Retinal fundus photograph. 2048 x 1536 pixels. FOV: 45 degrees
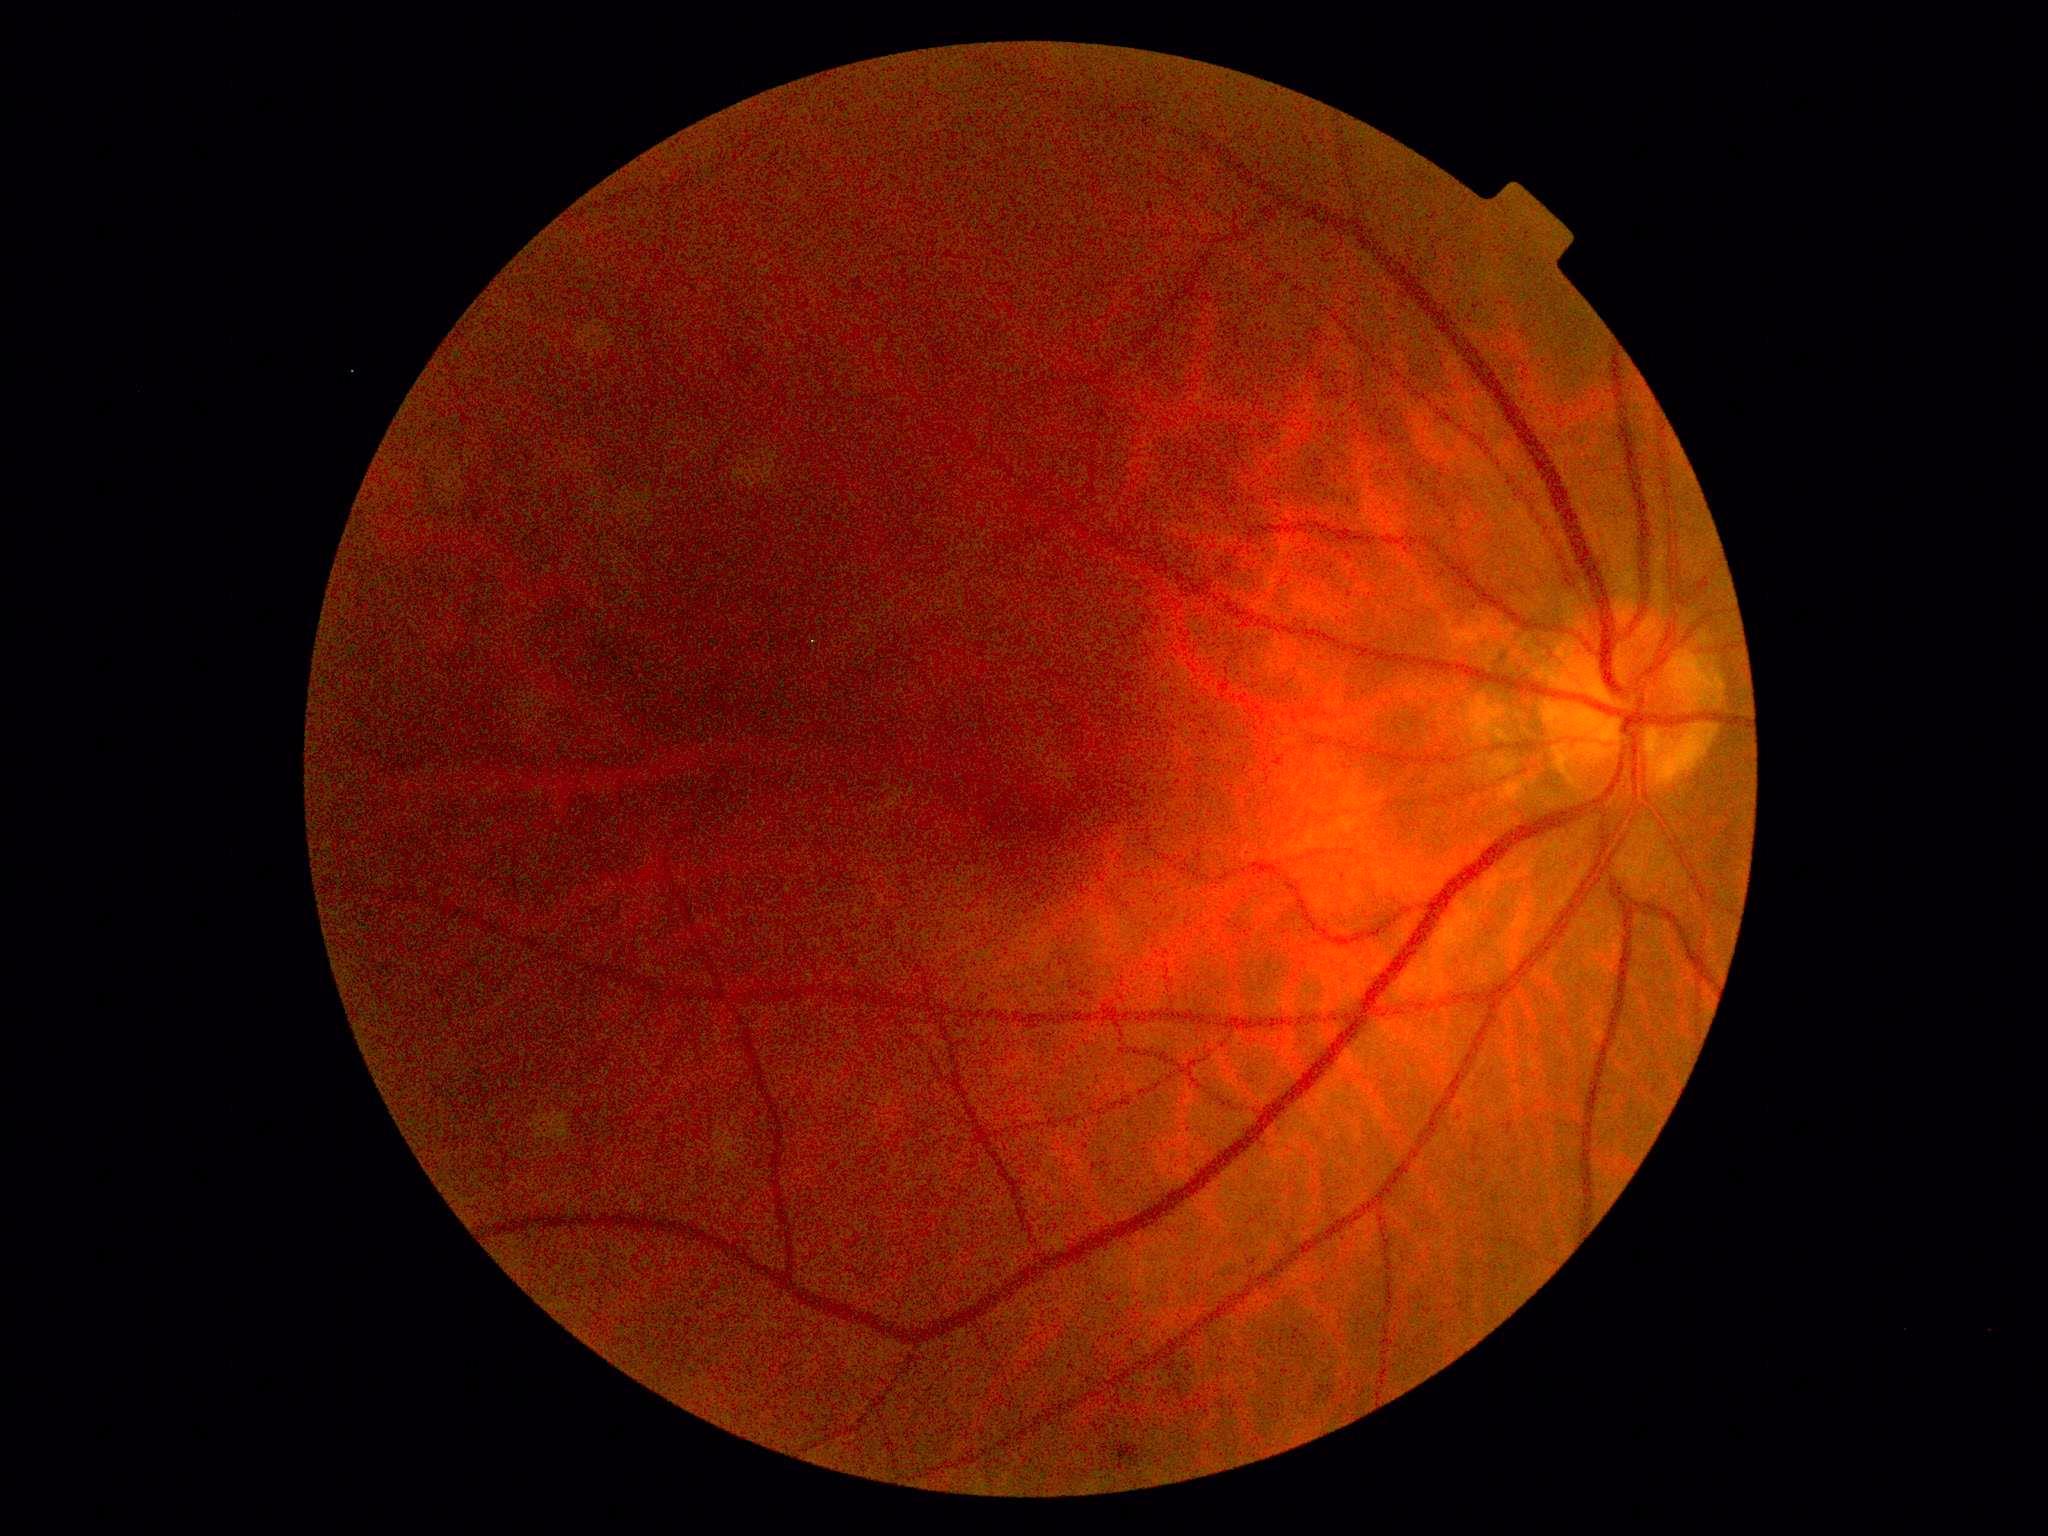
DR stage is 2/4.